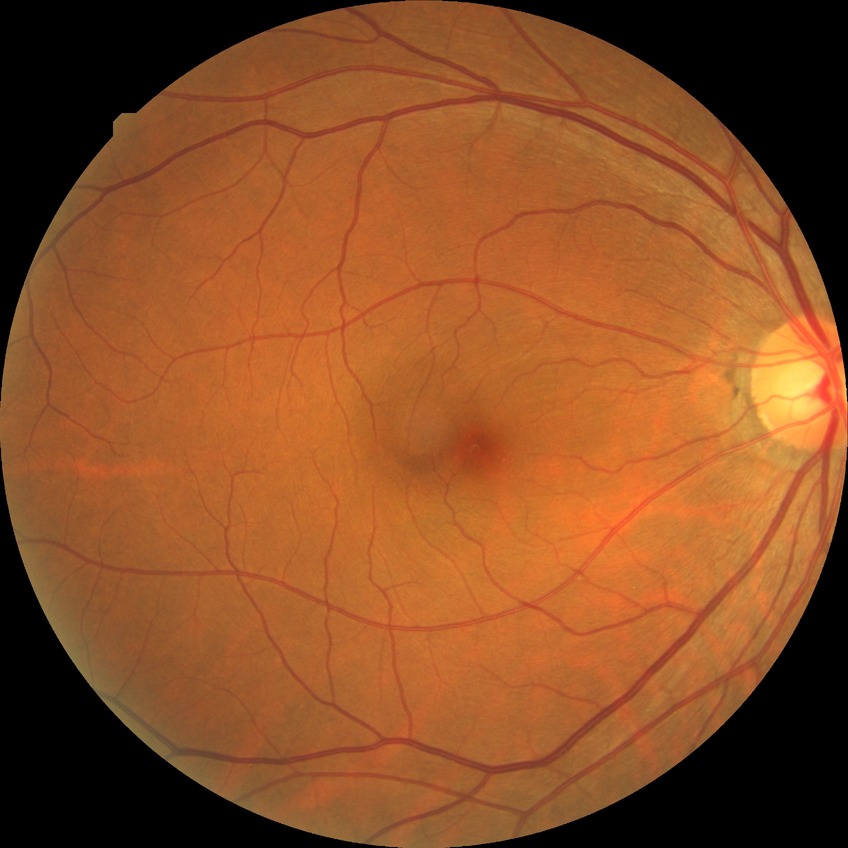 Retinopathy grade is no diabetic retinopathy.